FOV: 45 degrees:
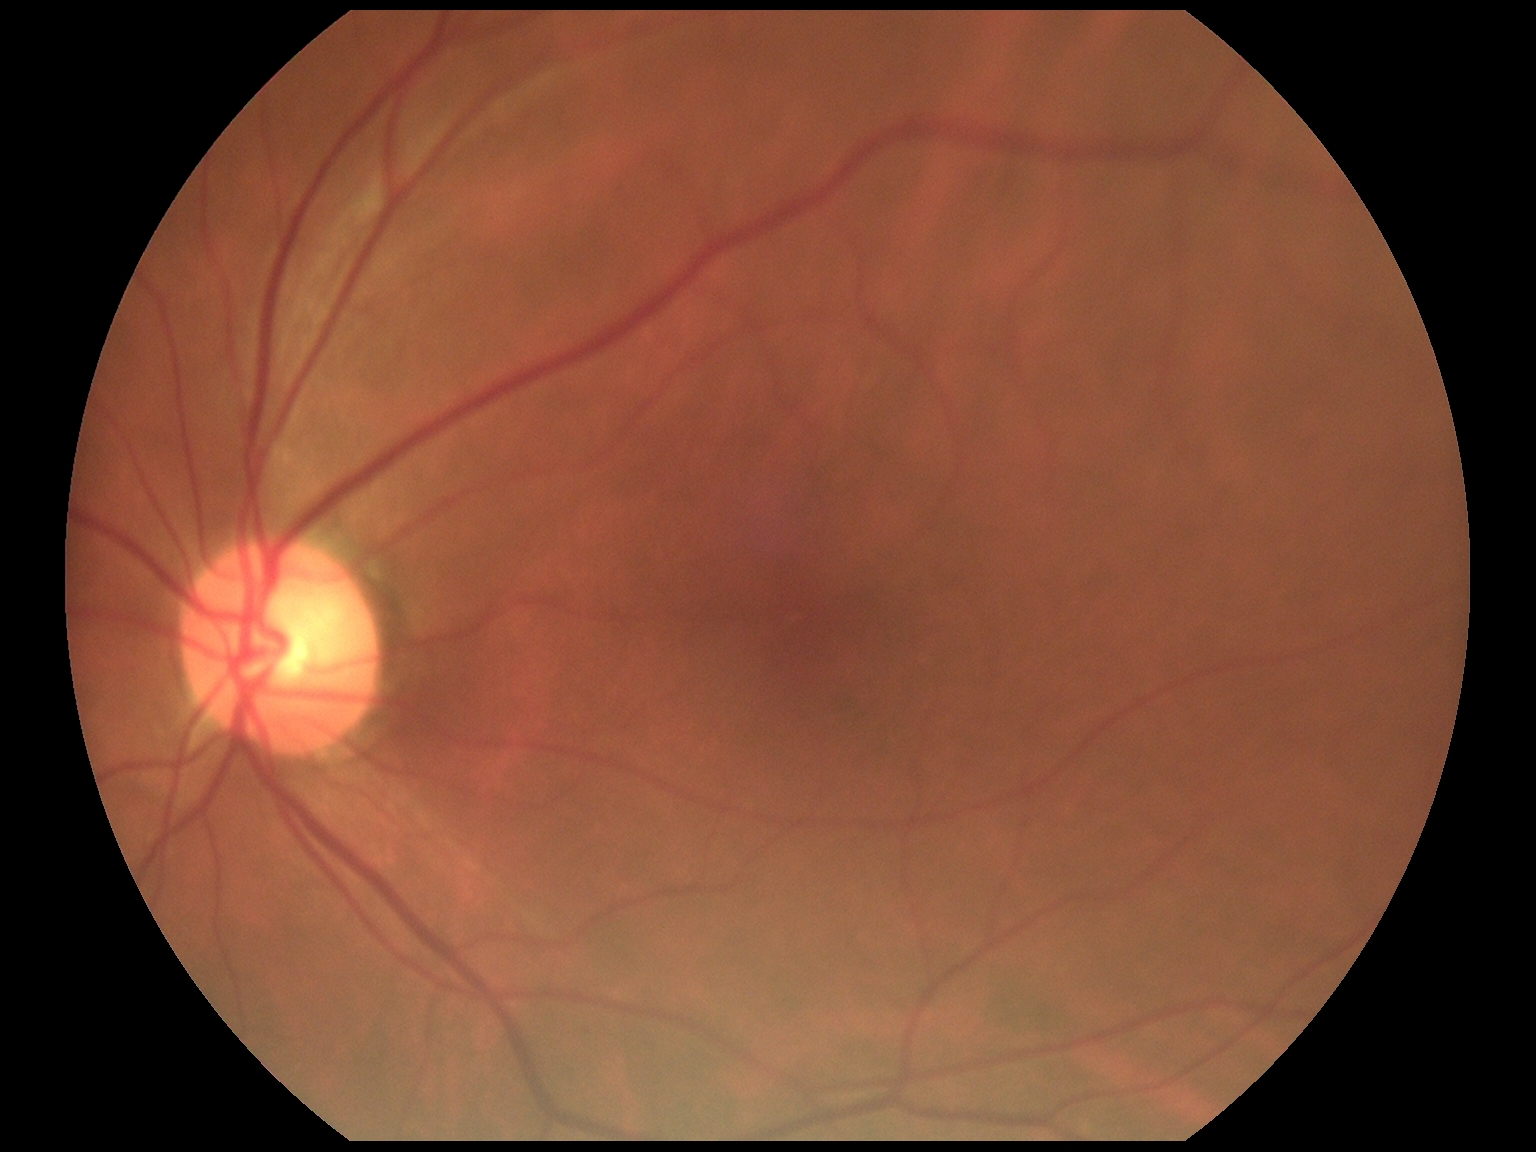
No DR findings.
Diabetic retinopathy (DR): grade 0.